Modified Davis grading. Nonmydriatic fundus photograph.
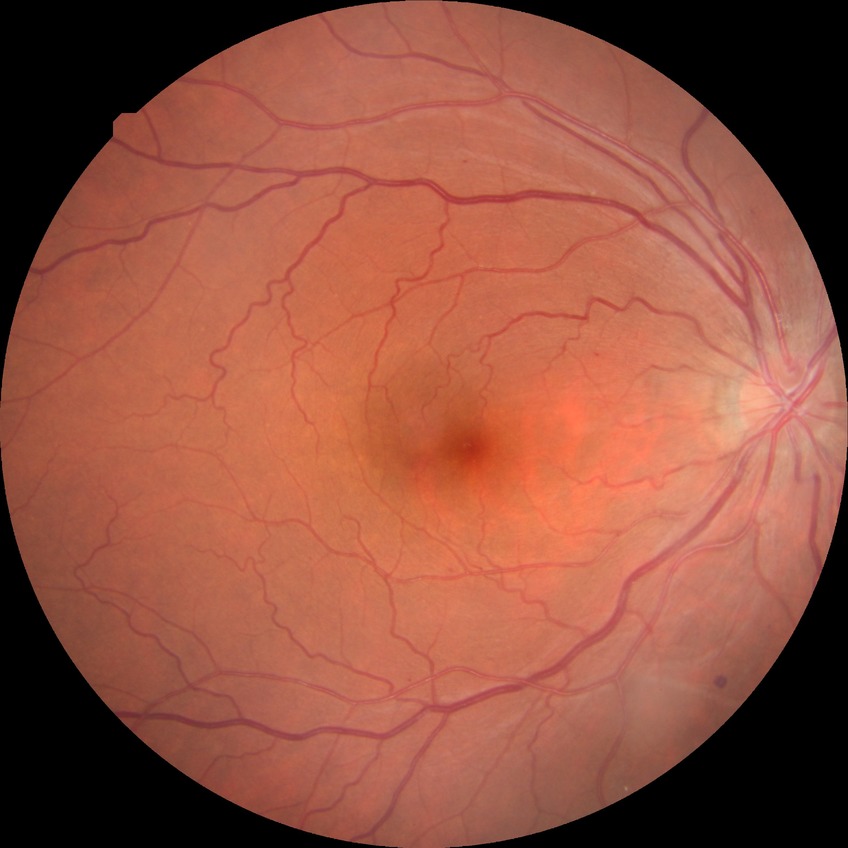 diabetic retinopathy (DR): SDR (simple diabetic retinopathy).